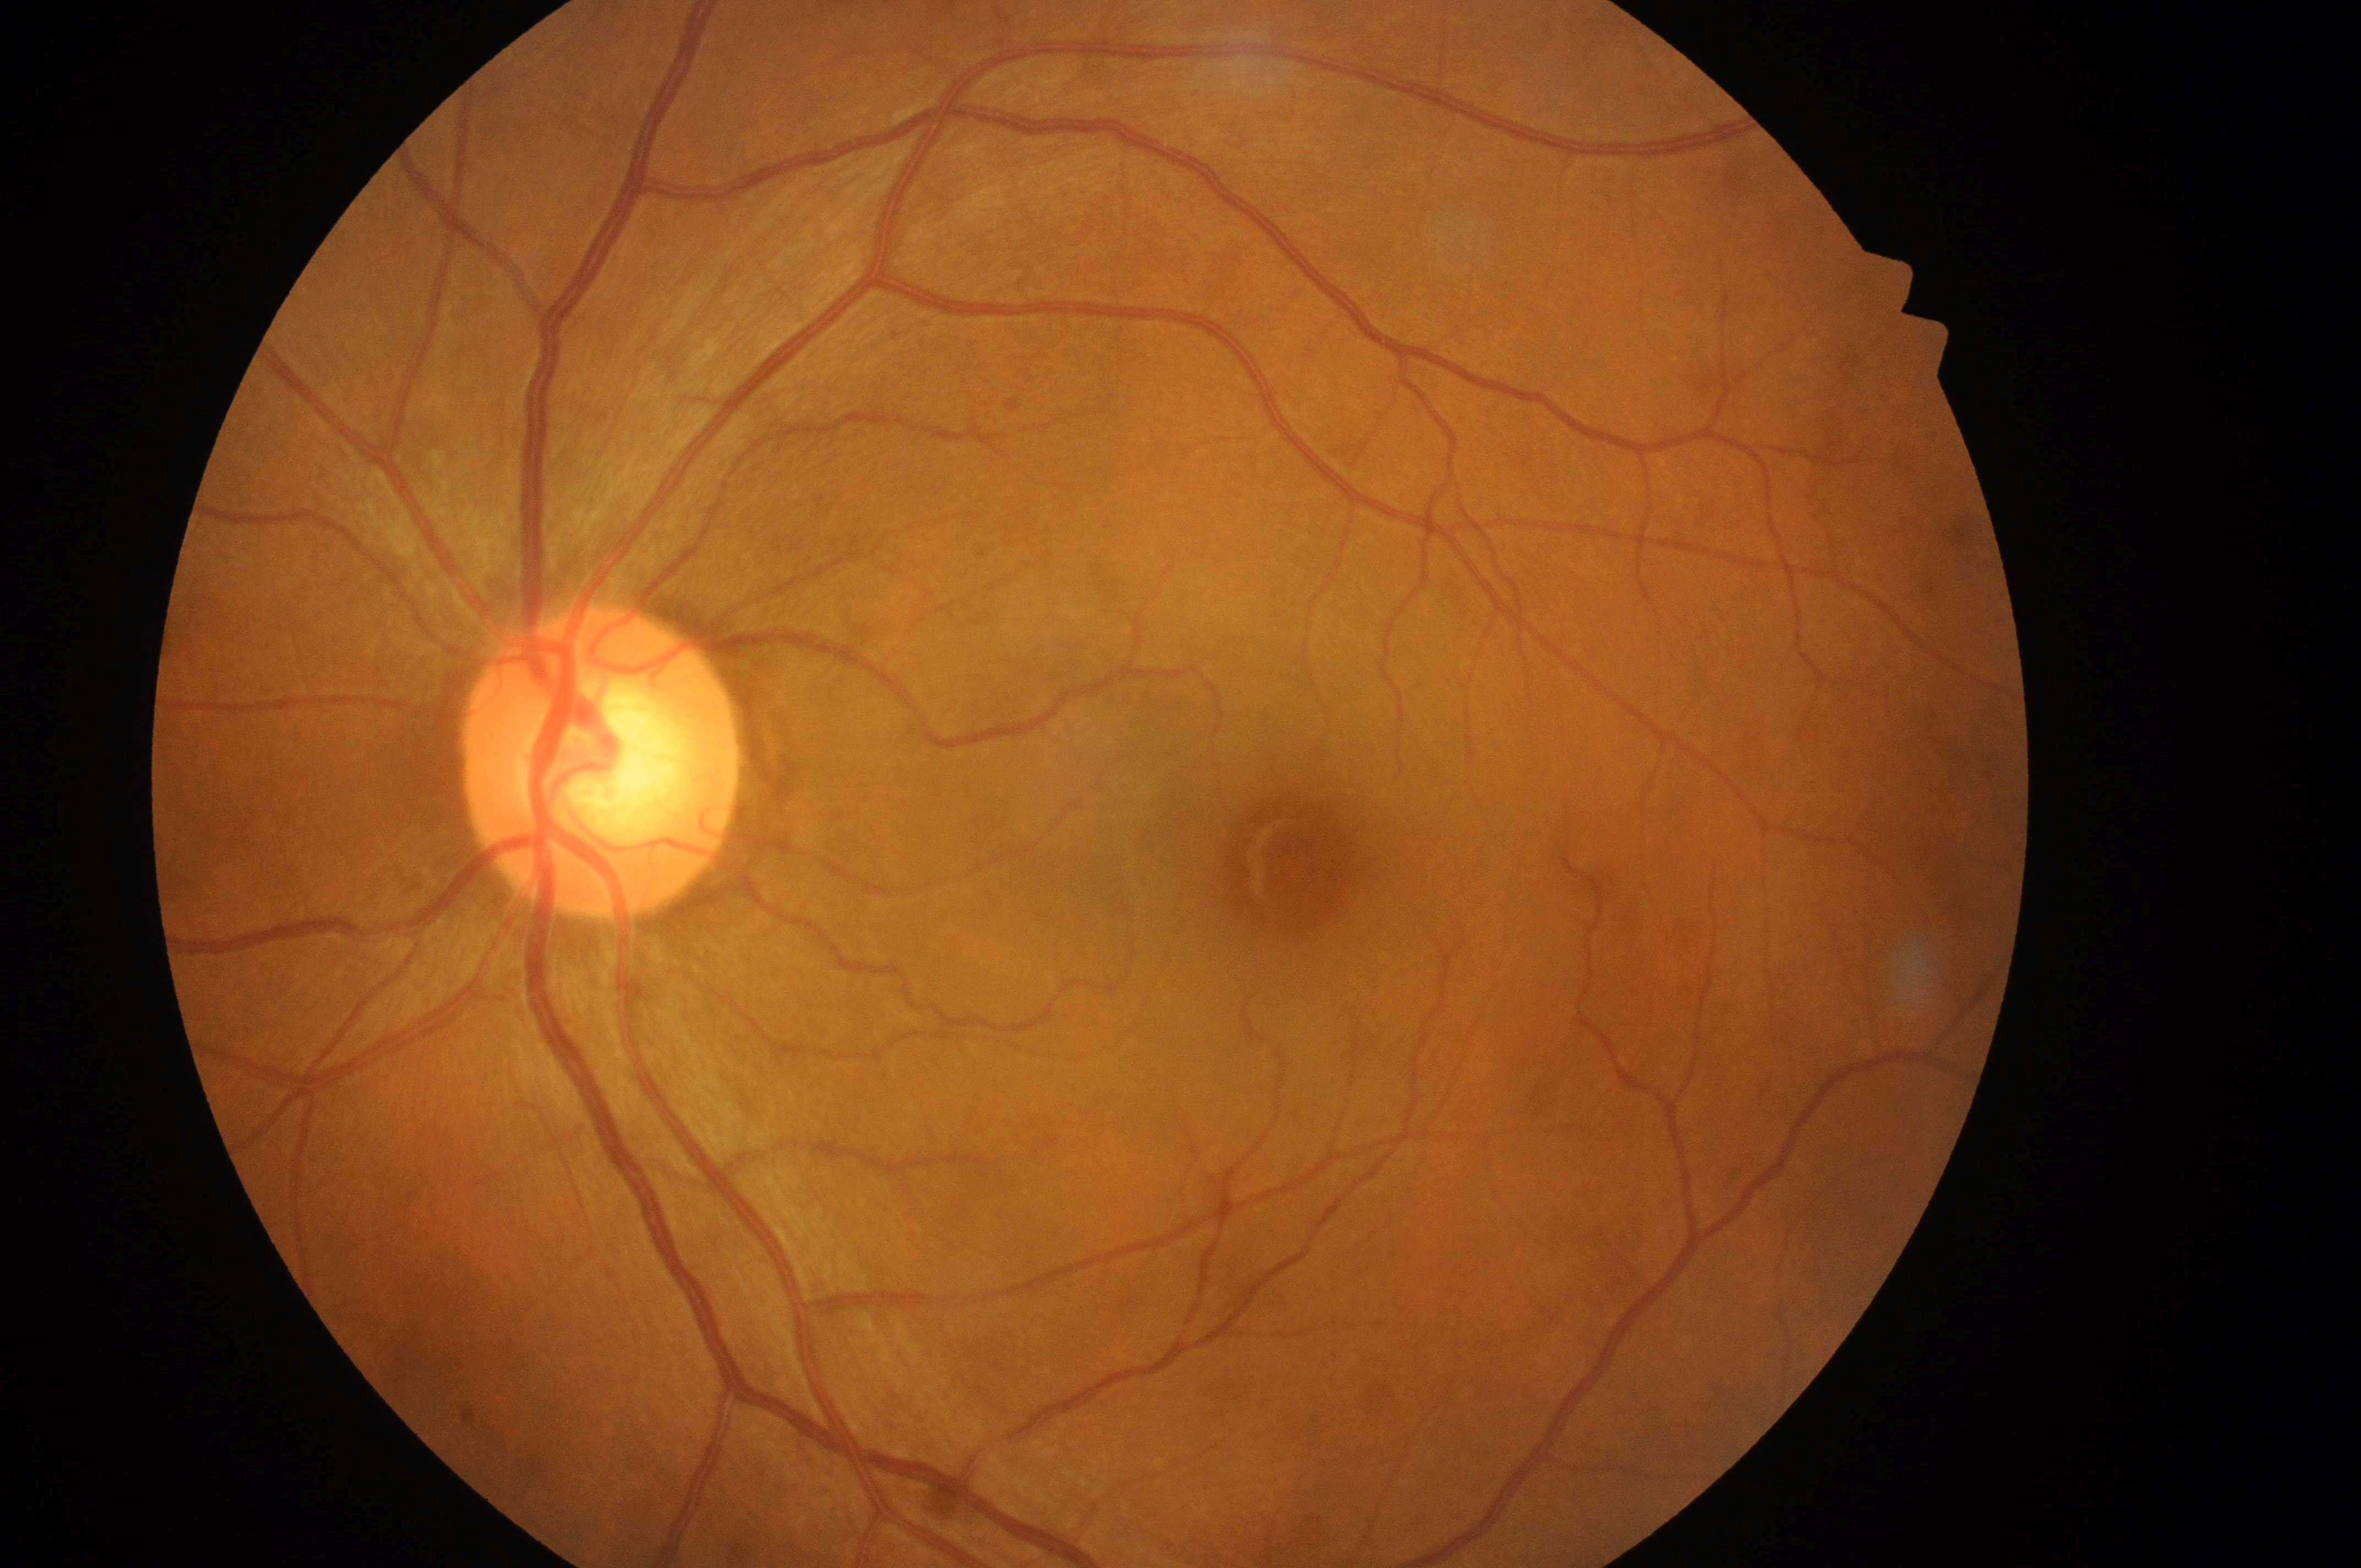 Retinopathy: grade 0. Fovea: 1287, 874. Imaged eye: left. The optic disk is at 594, 773. Diabetic macular edema: 0.